CFP: 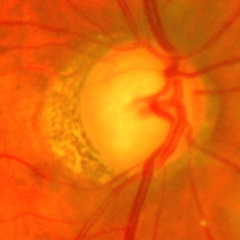

Optic disc appearance consistent with advanced-stage glaucoma. Defined as near-total cupping of the optic nerve head, with or without severe visual field loss within the central 10 degrees of fixation.